Infant wide-field retinal image; Clarity RetCam 3, 130° FOV — 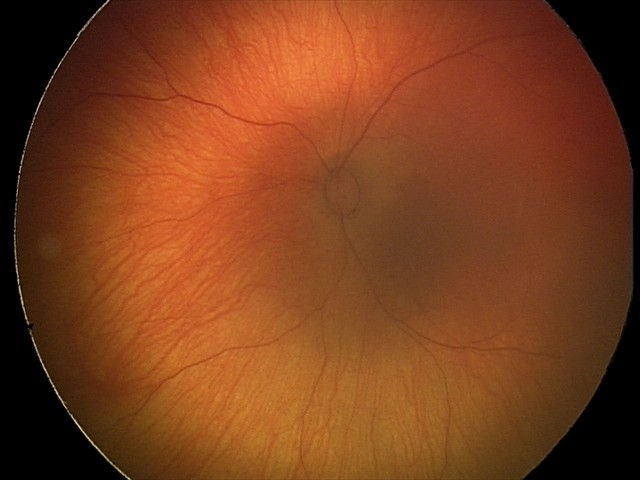

Q: What is the diagnosis from this examination?
A: physiological finding